45 degree fundus photograph:
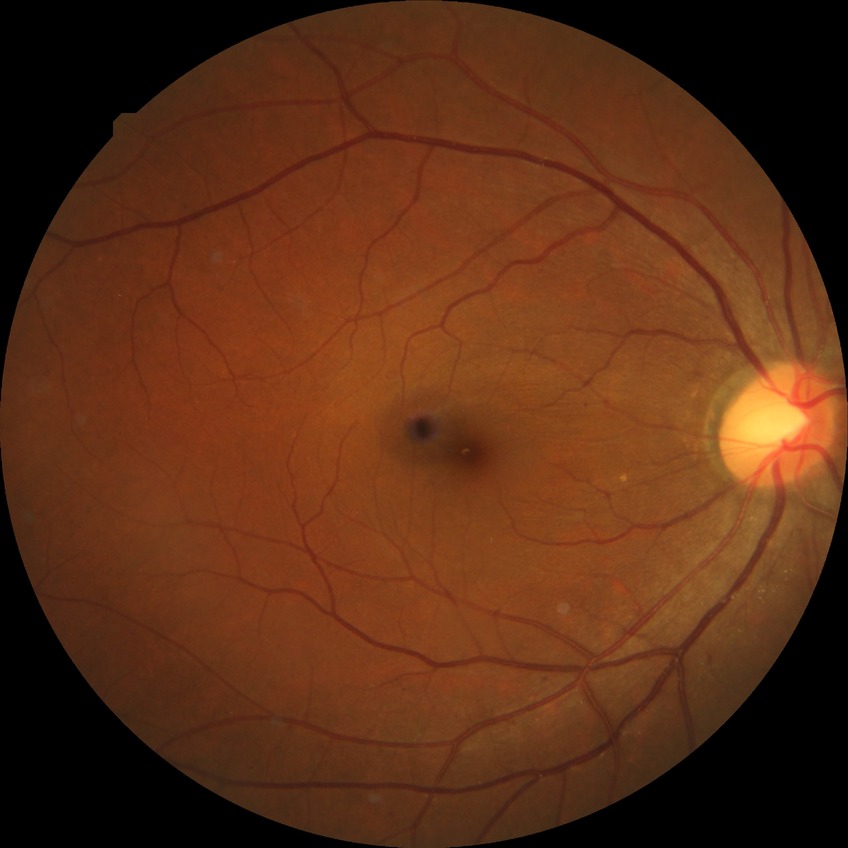

* DR class: non-proliferative diabetic retinopathy
* modified Davis grading: simple diabetic retinopathy